2352x1568px · 45° field of view:
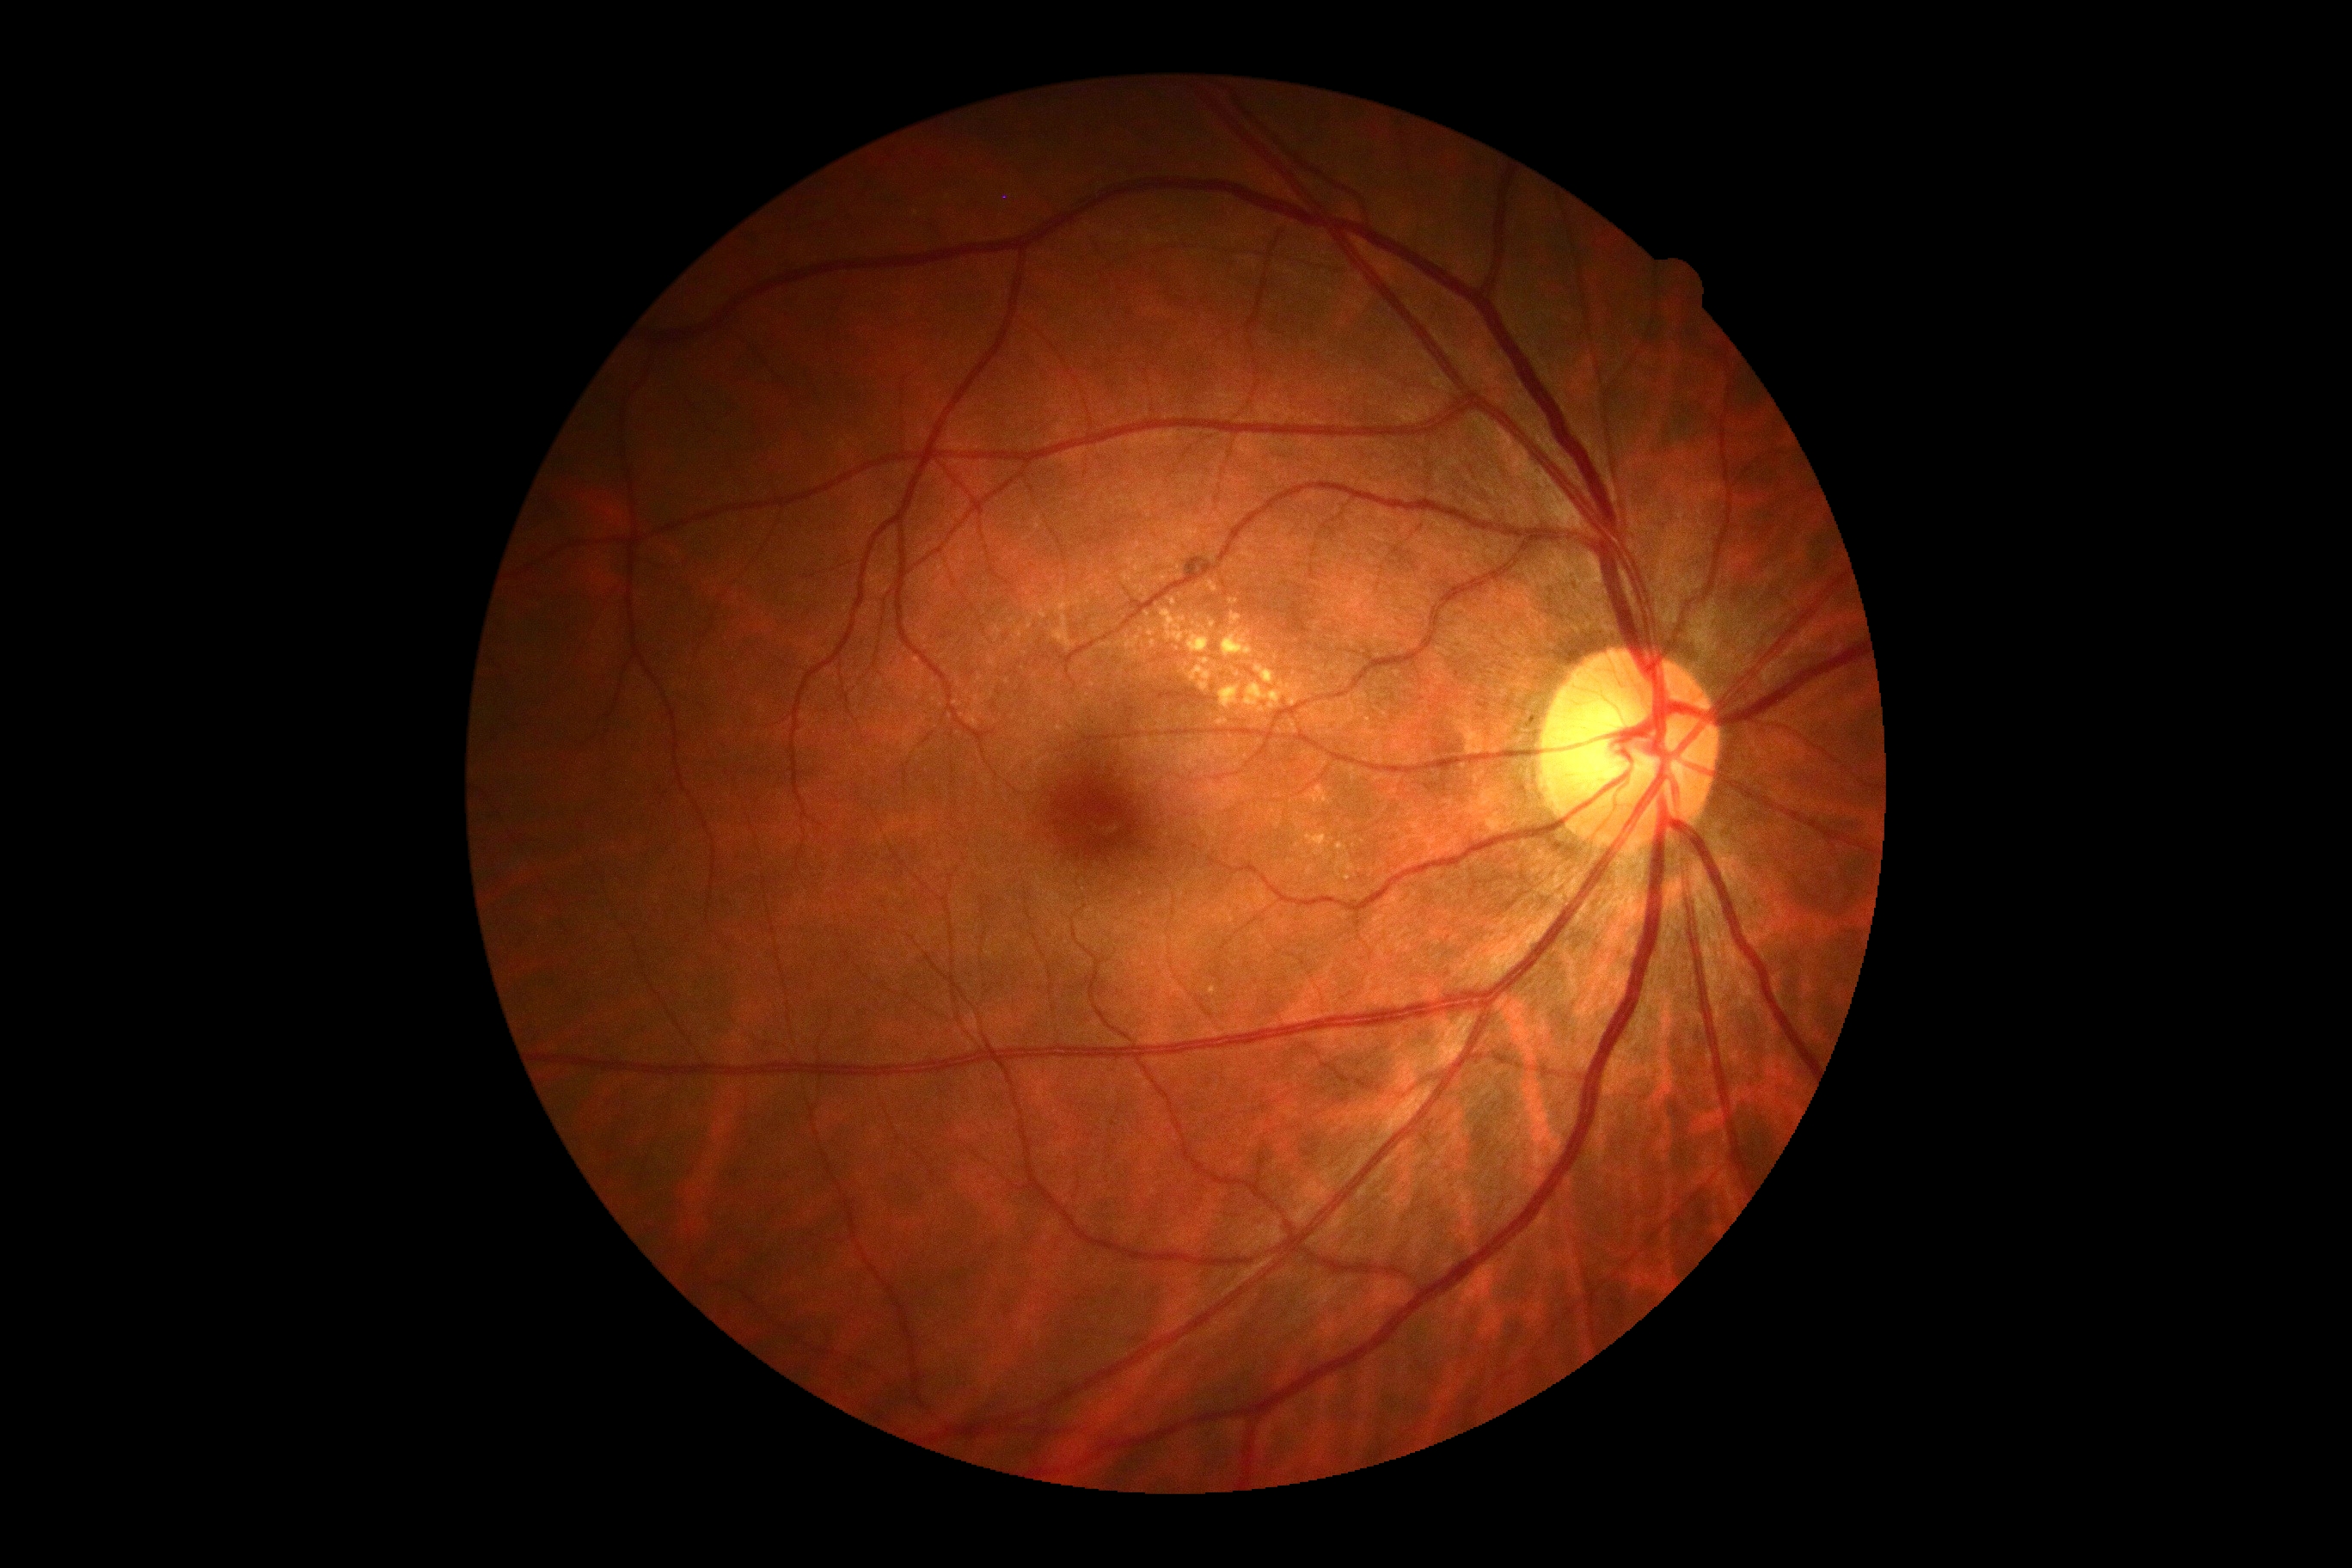
Diabetic retinopathy severity is grade 2 — more than just microaneurysms but less than severe NPDR. No soft exudates identified. Hard exudates include lesions at (x1=1228, y1=599, x2=1239, y2=606), (x1=1189, y1=666, x2=1213, y2=692), (x1=1230, y1=613, x2=1242, y2=627), (x1=1222, y1=632, x2=1253, y2=658), (x1=1149, y1=640, x2=1156, y2=649), (x1=1187, y1=632, x2=1210, y2=654), (x1=1256, y1=665, x2=1275, y2=685), (x1=1244, y1=683, x2=1302, y2=711), (x1=1220, y1=720, x2=1228, y2=723), (x1=1201, y1=659, x2=1210, y2=665). Hard exudates (small, approximate centers) near Point(1212, 625), Point(1173, 602), Point(1147, 614). Hemorrhages are located at (x1=1185, y1=558, x2=1213, y2=579). No microaneurysms identified.